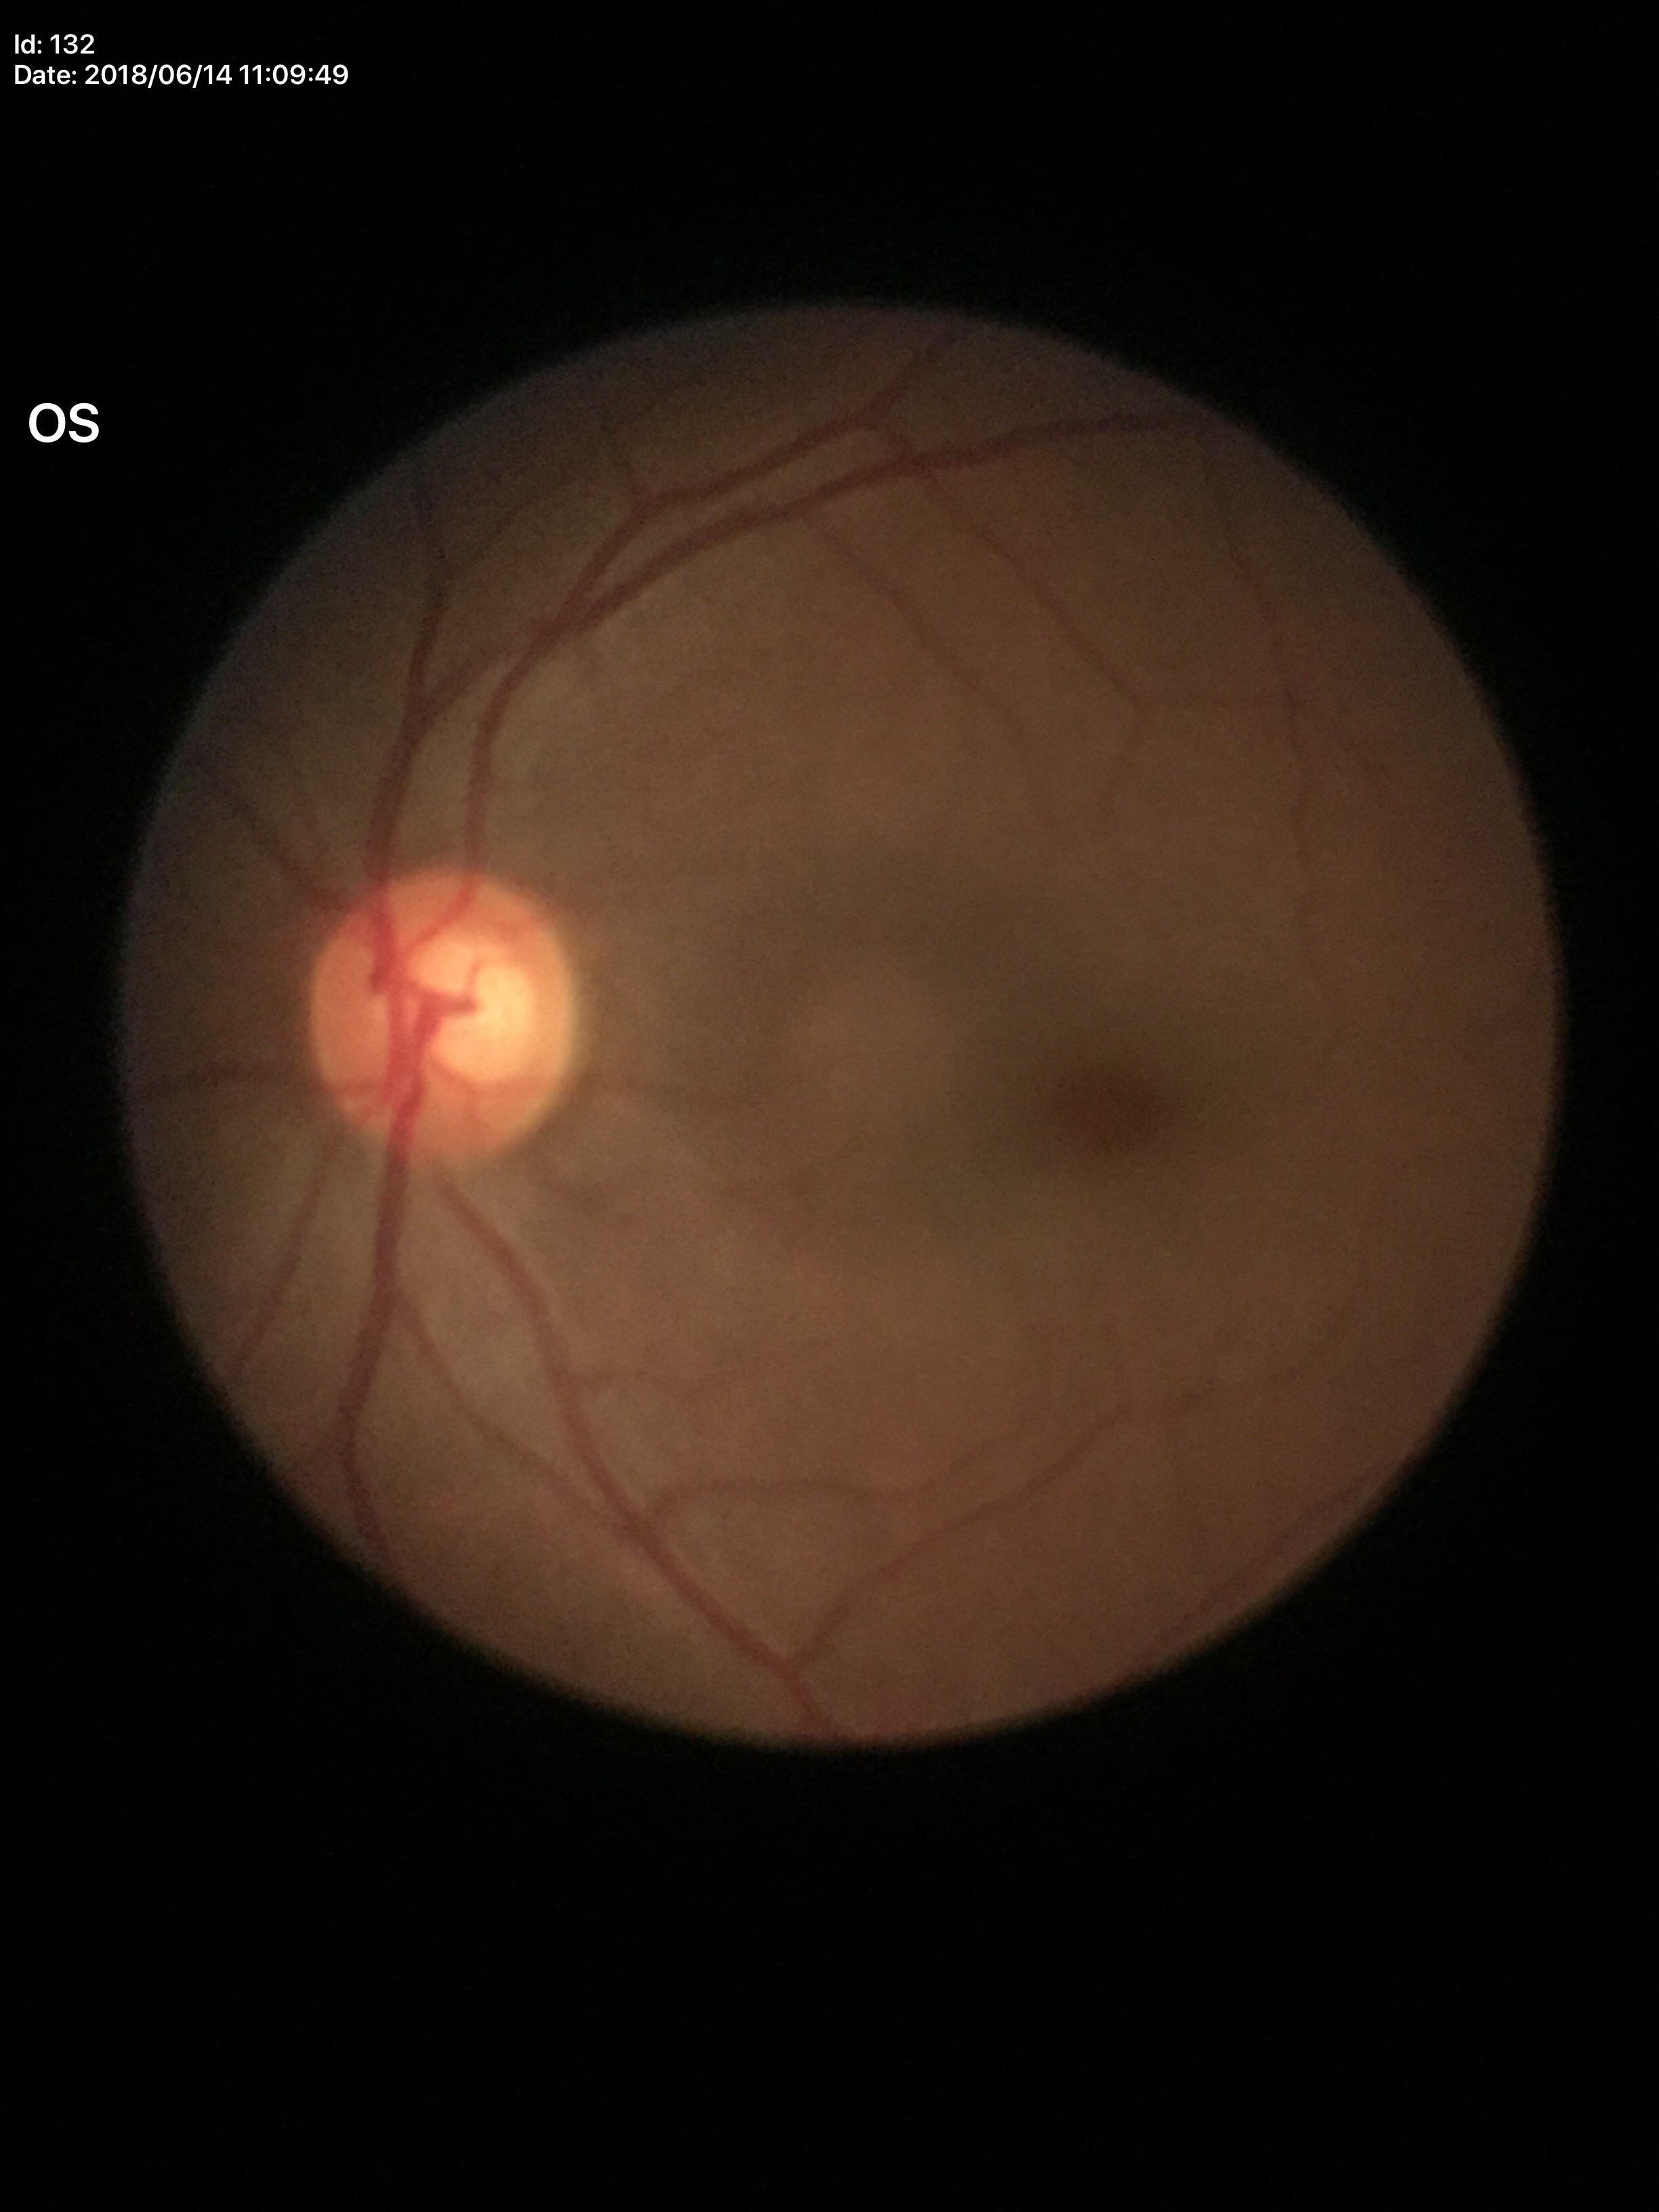 Glaucoma evaluation: not suspect. Vertical C/D ratio: 0.57.